Color fundus image
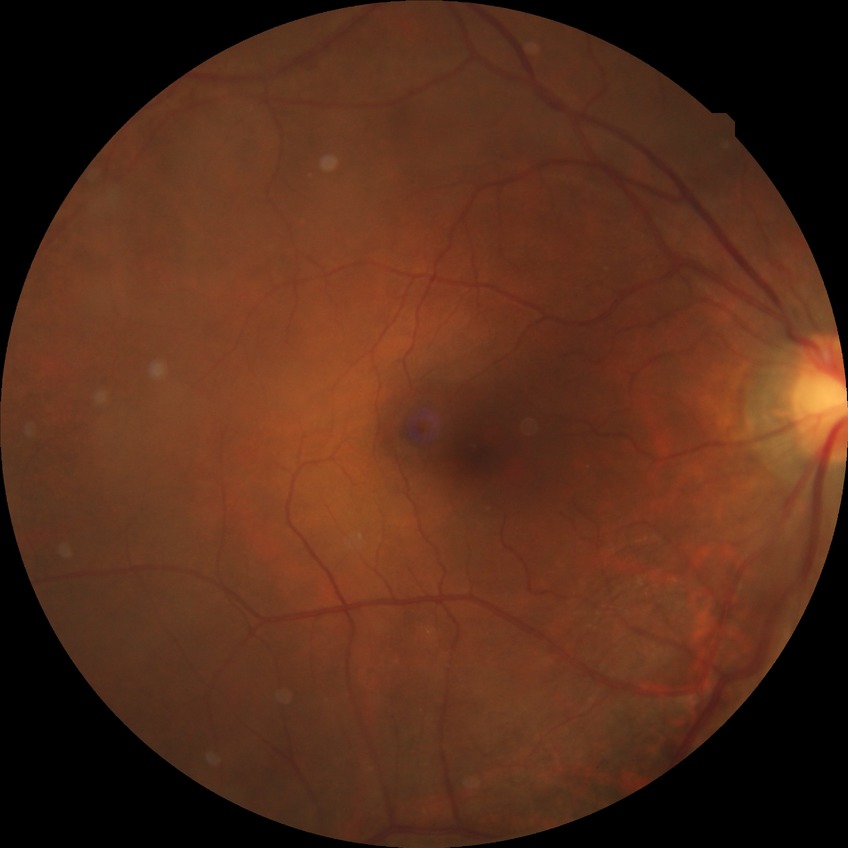
diabetic retinopathy grade: no diabetic retinopathy.